Wide-field fundus photograph from neonatal ROP screening
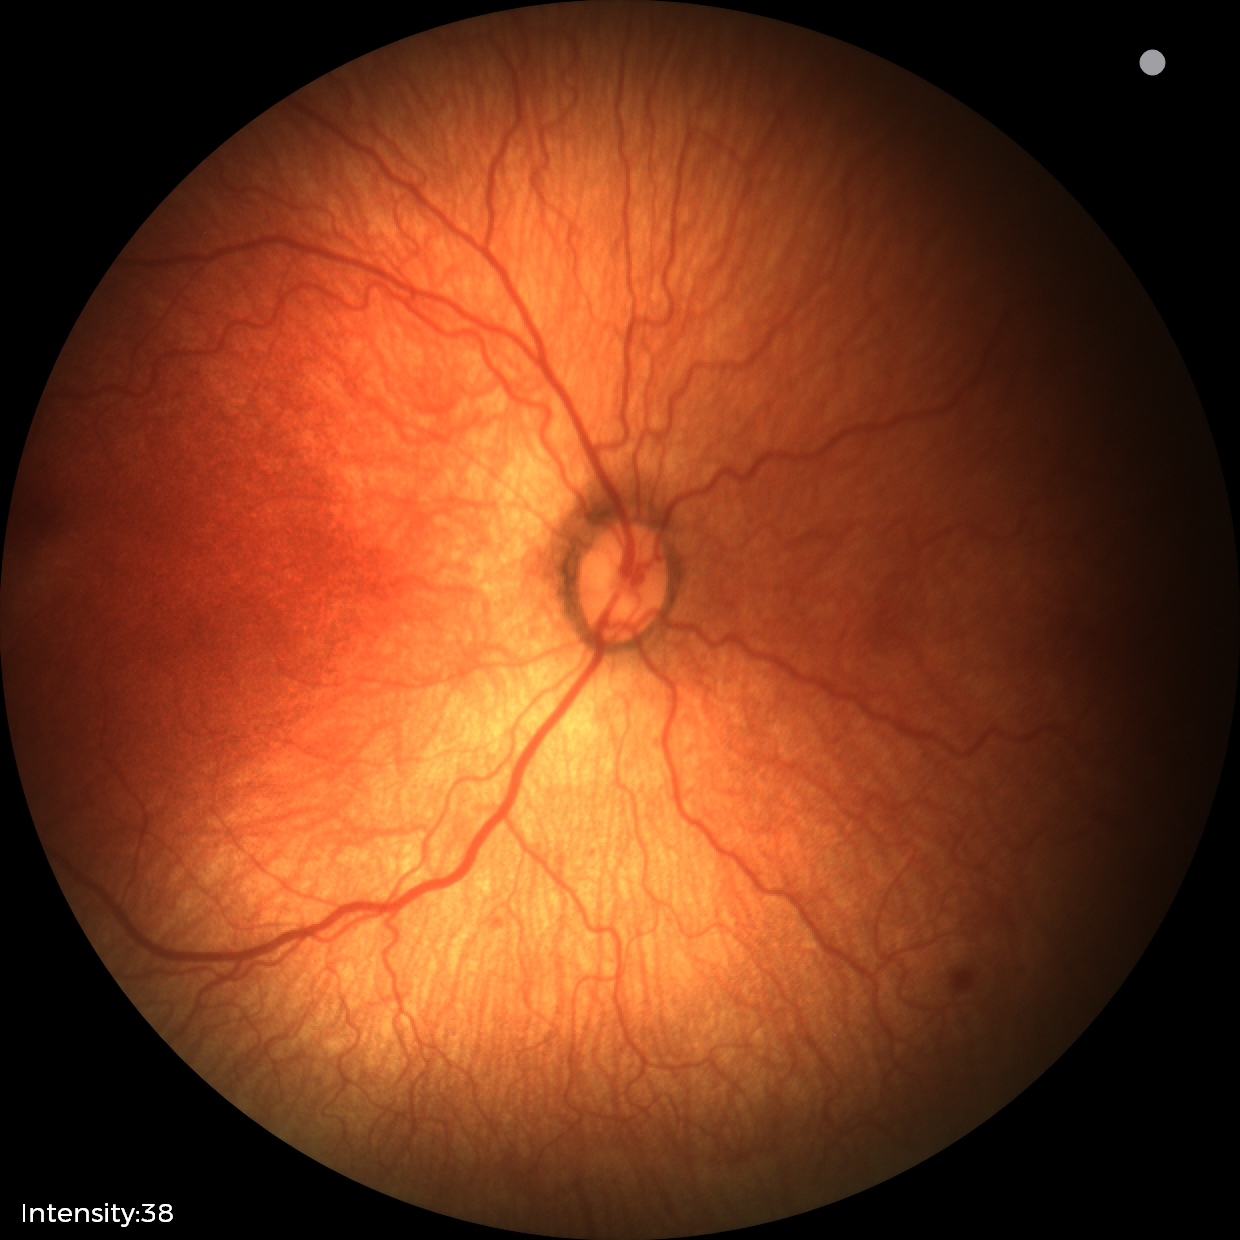
Screening series with retinopathy of prematurity (ROP) stage 1 — demarcation line between vascular and avascular retina. Without plus disease.